640 x 480 pixels; wide-field fundus photograph of an infant:
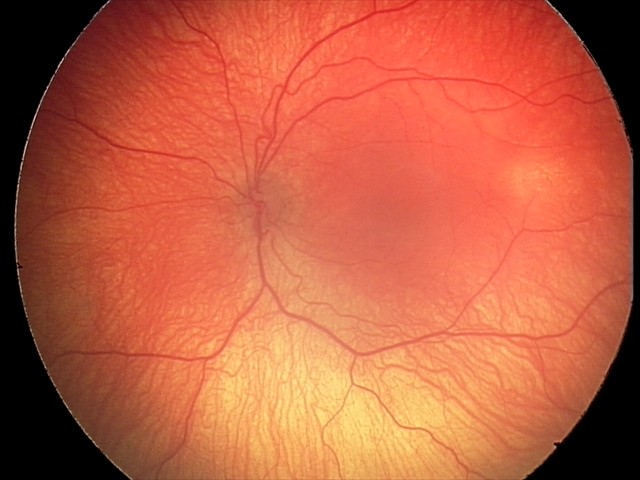
Without plus disease.
Series diagnosed as retinopathy of prematurity stage 2 — ridge with height and width at the demarcation line.